2048 x 1536 pixels:
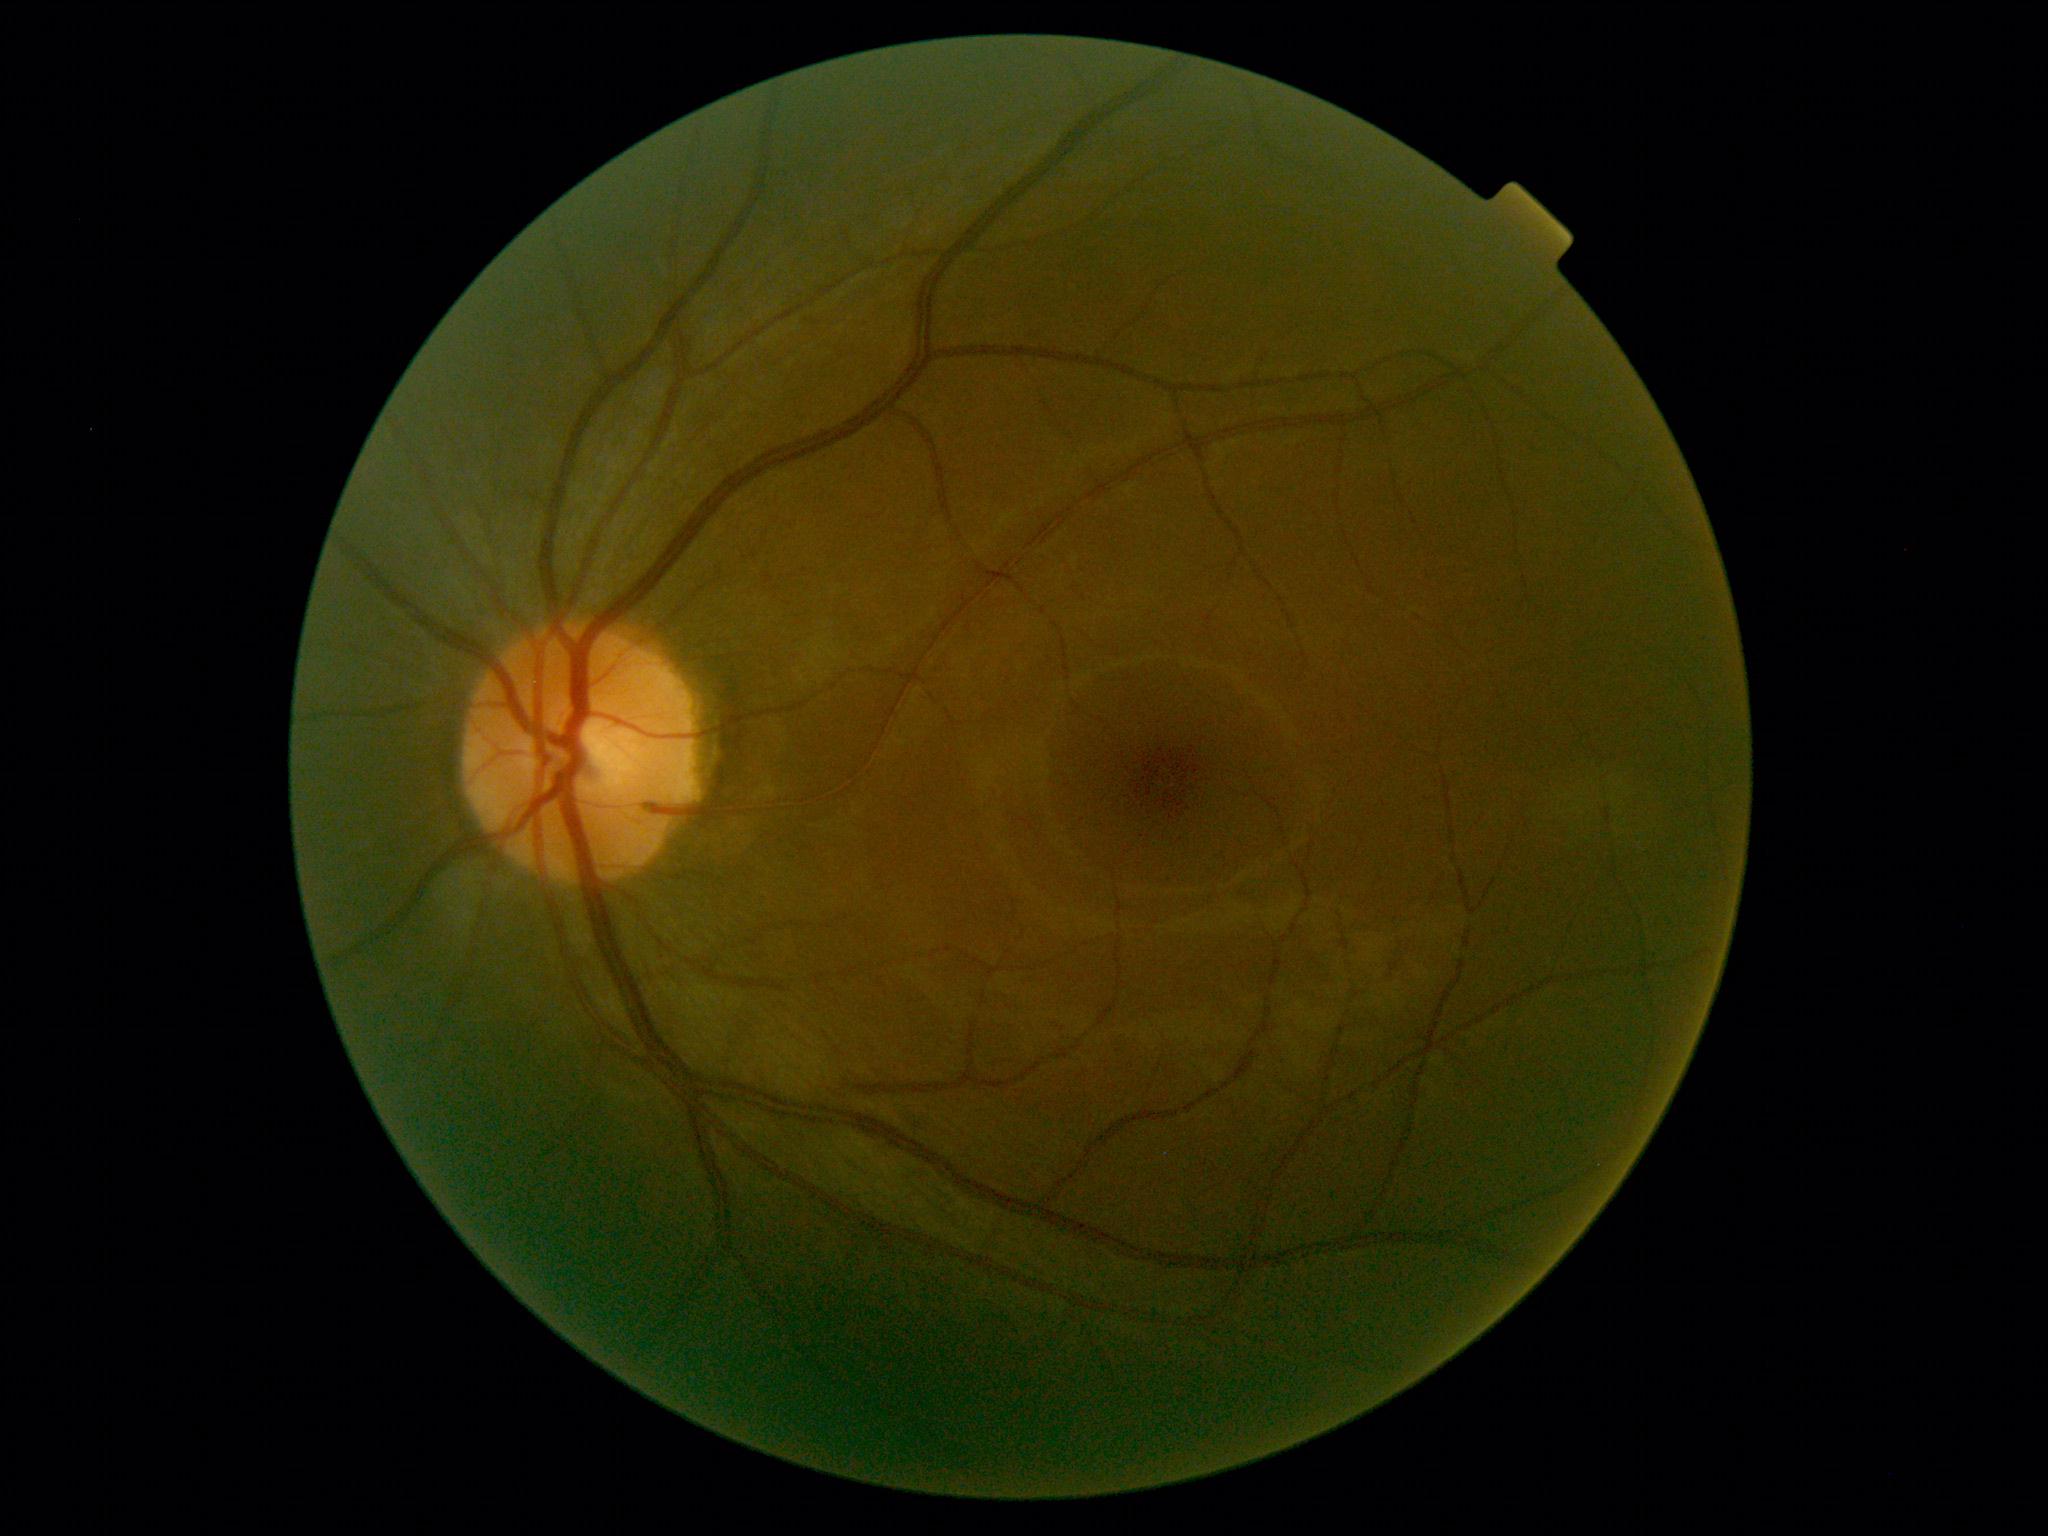

DR impression = no signs of DR
DR = grade 0